1240x1240px · 100° field of view (Phoenix ICON) · infant wide-field fundus photograph:
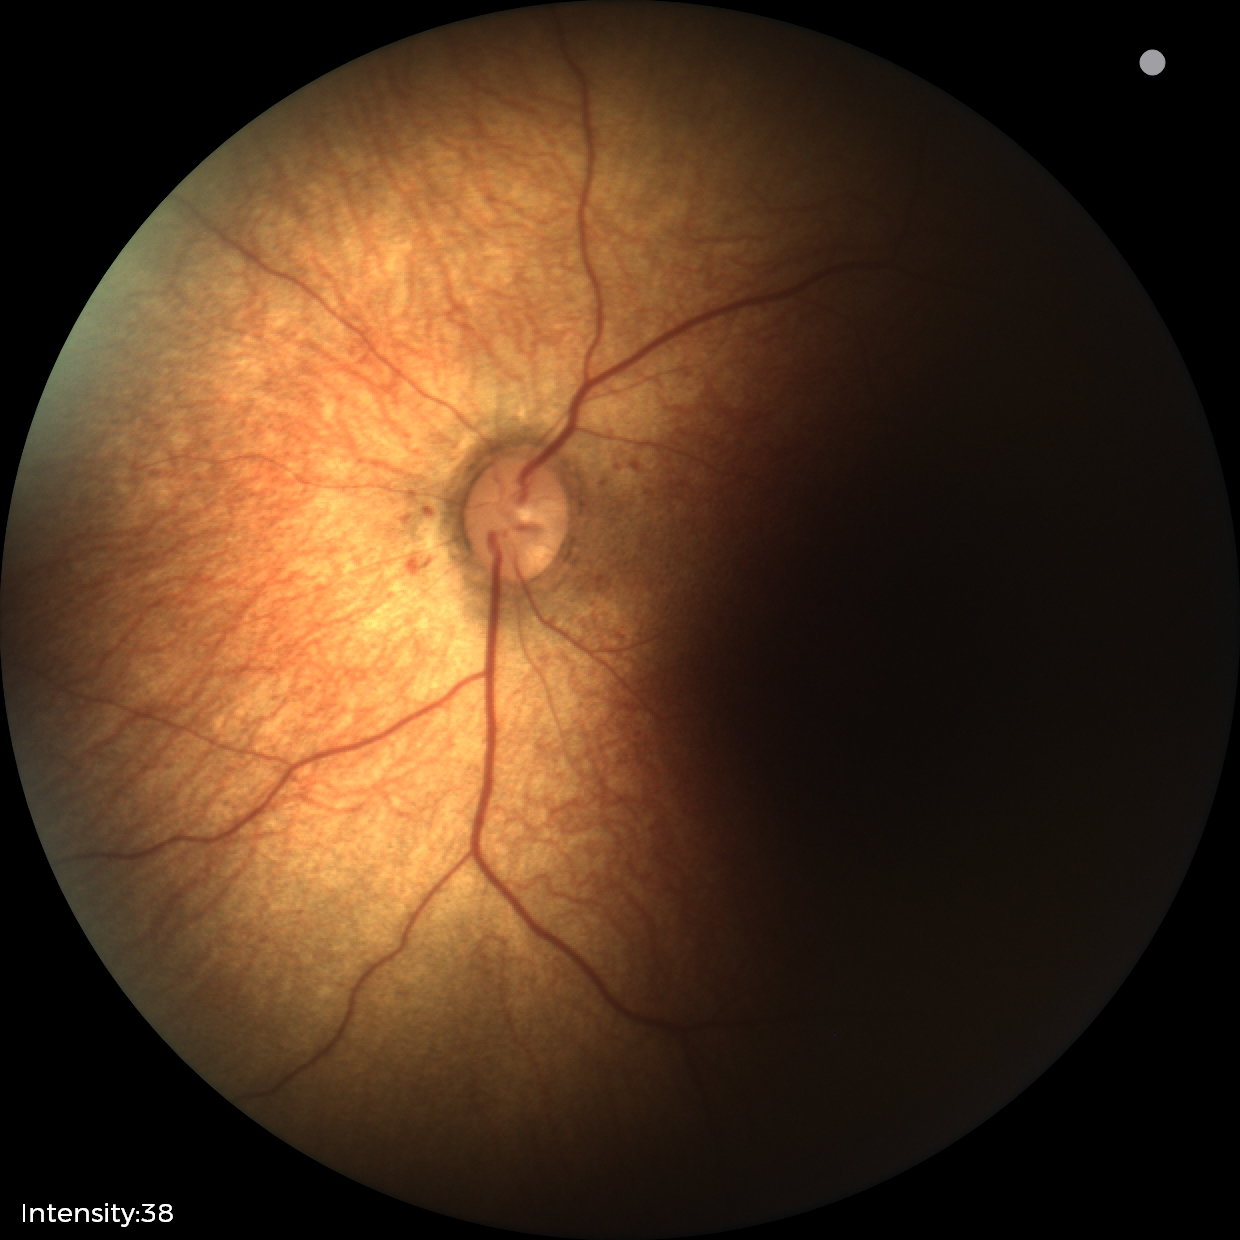

Screening examination with no abnormal retinal findings.